45-degree field of view. CFP:
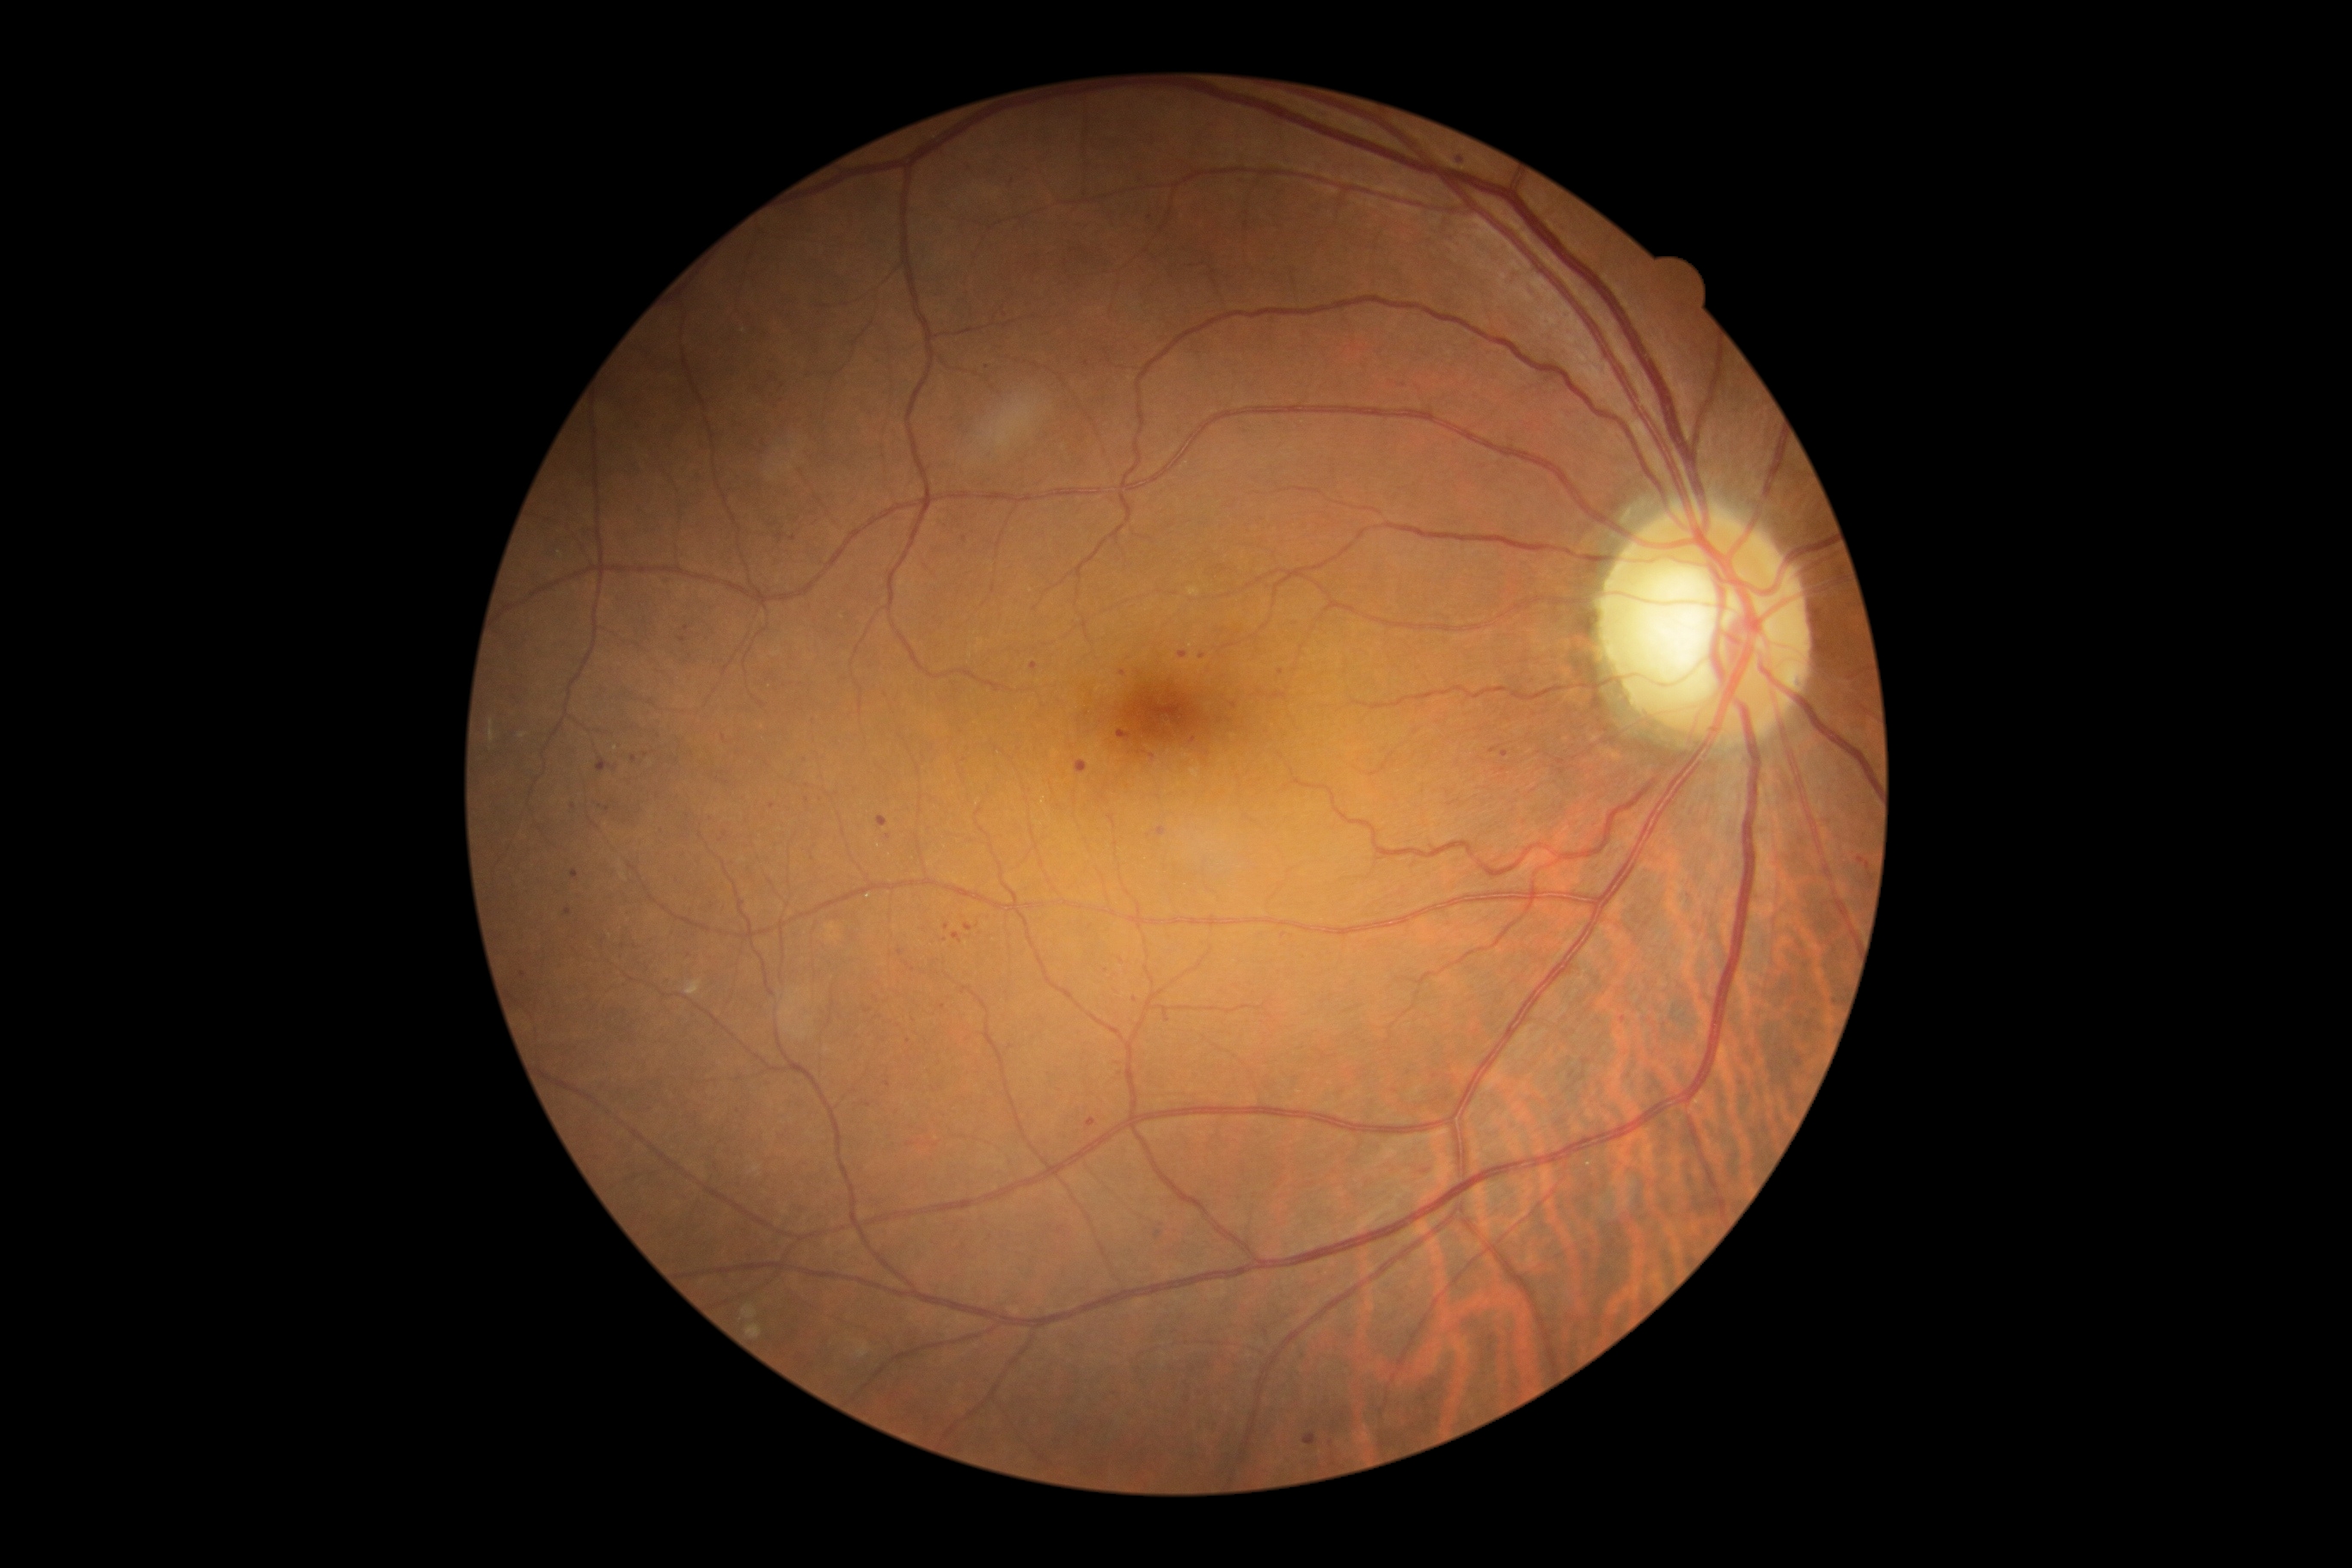

Diabetic retinopathy (DR): grade 1; non-proliferative diabetic retinopathy
Selected lesions:
microaneurysms (MAs) (subset) = 907:964:914:972 | 1304:1435:1316:1447 | 1179:652:1187:659 | 1156:828:1167:836
Small MAs near 1460:160 | 574:806 | 1122:673 | 718:779 | 624:946 | 686:628 | 1149:836 | 1233:705 | 1122:961 | 876:1016 | 1220:722 | 908:1041 | 793:539